2212x1659px; 45-degree field of view:
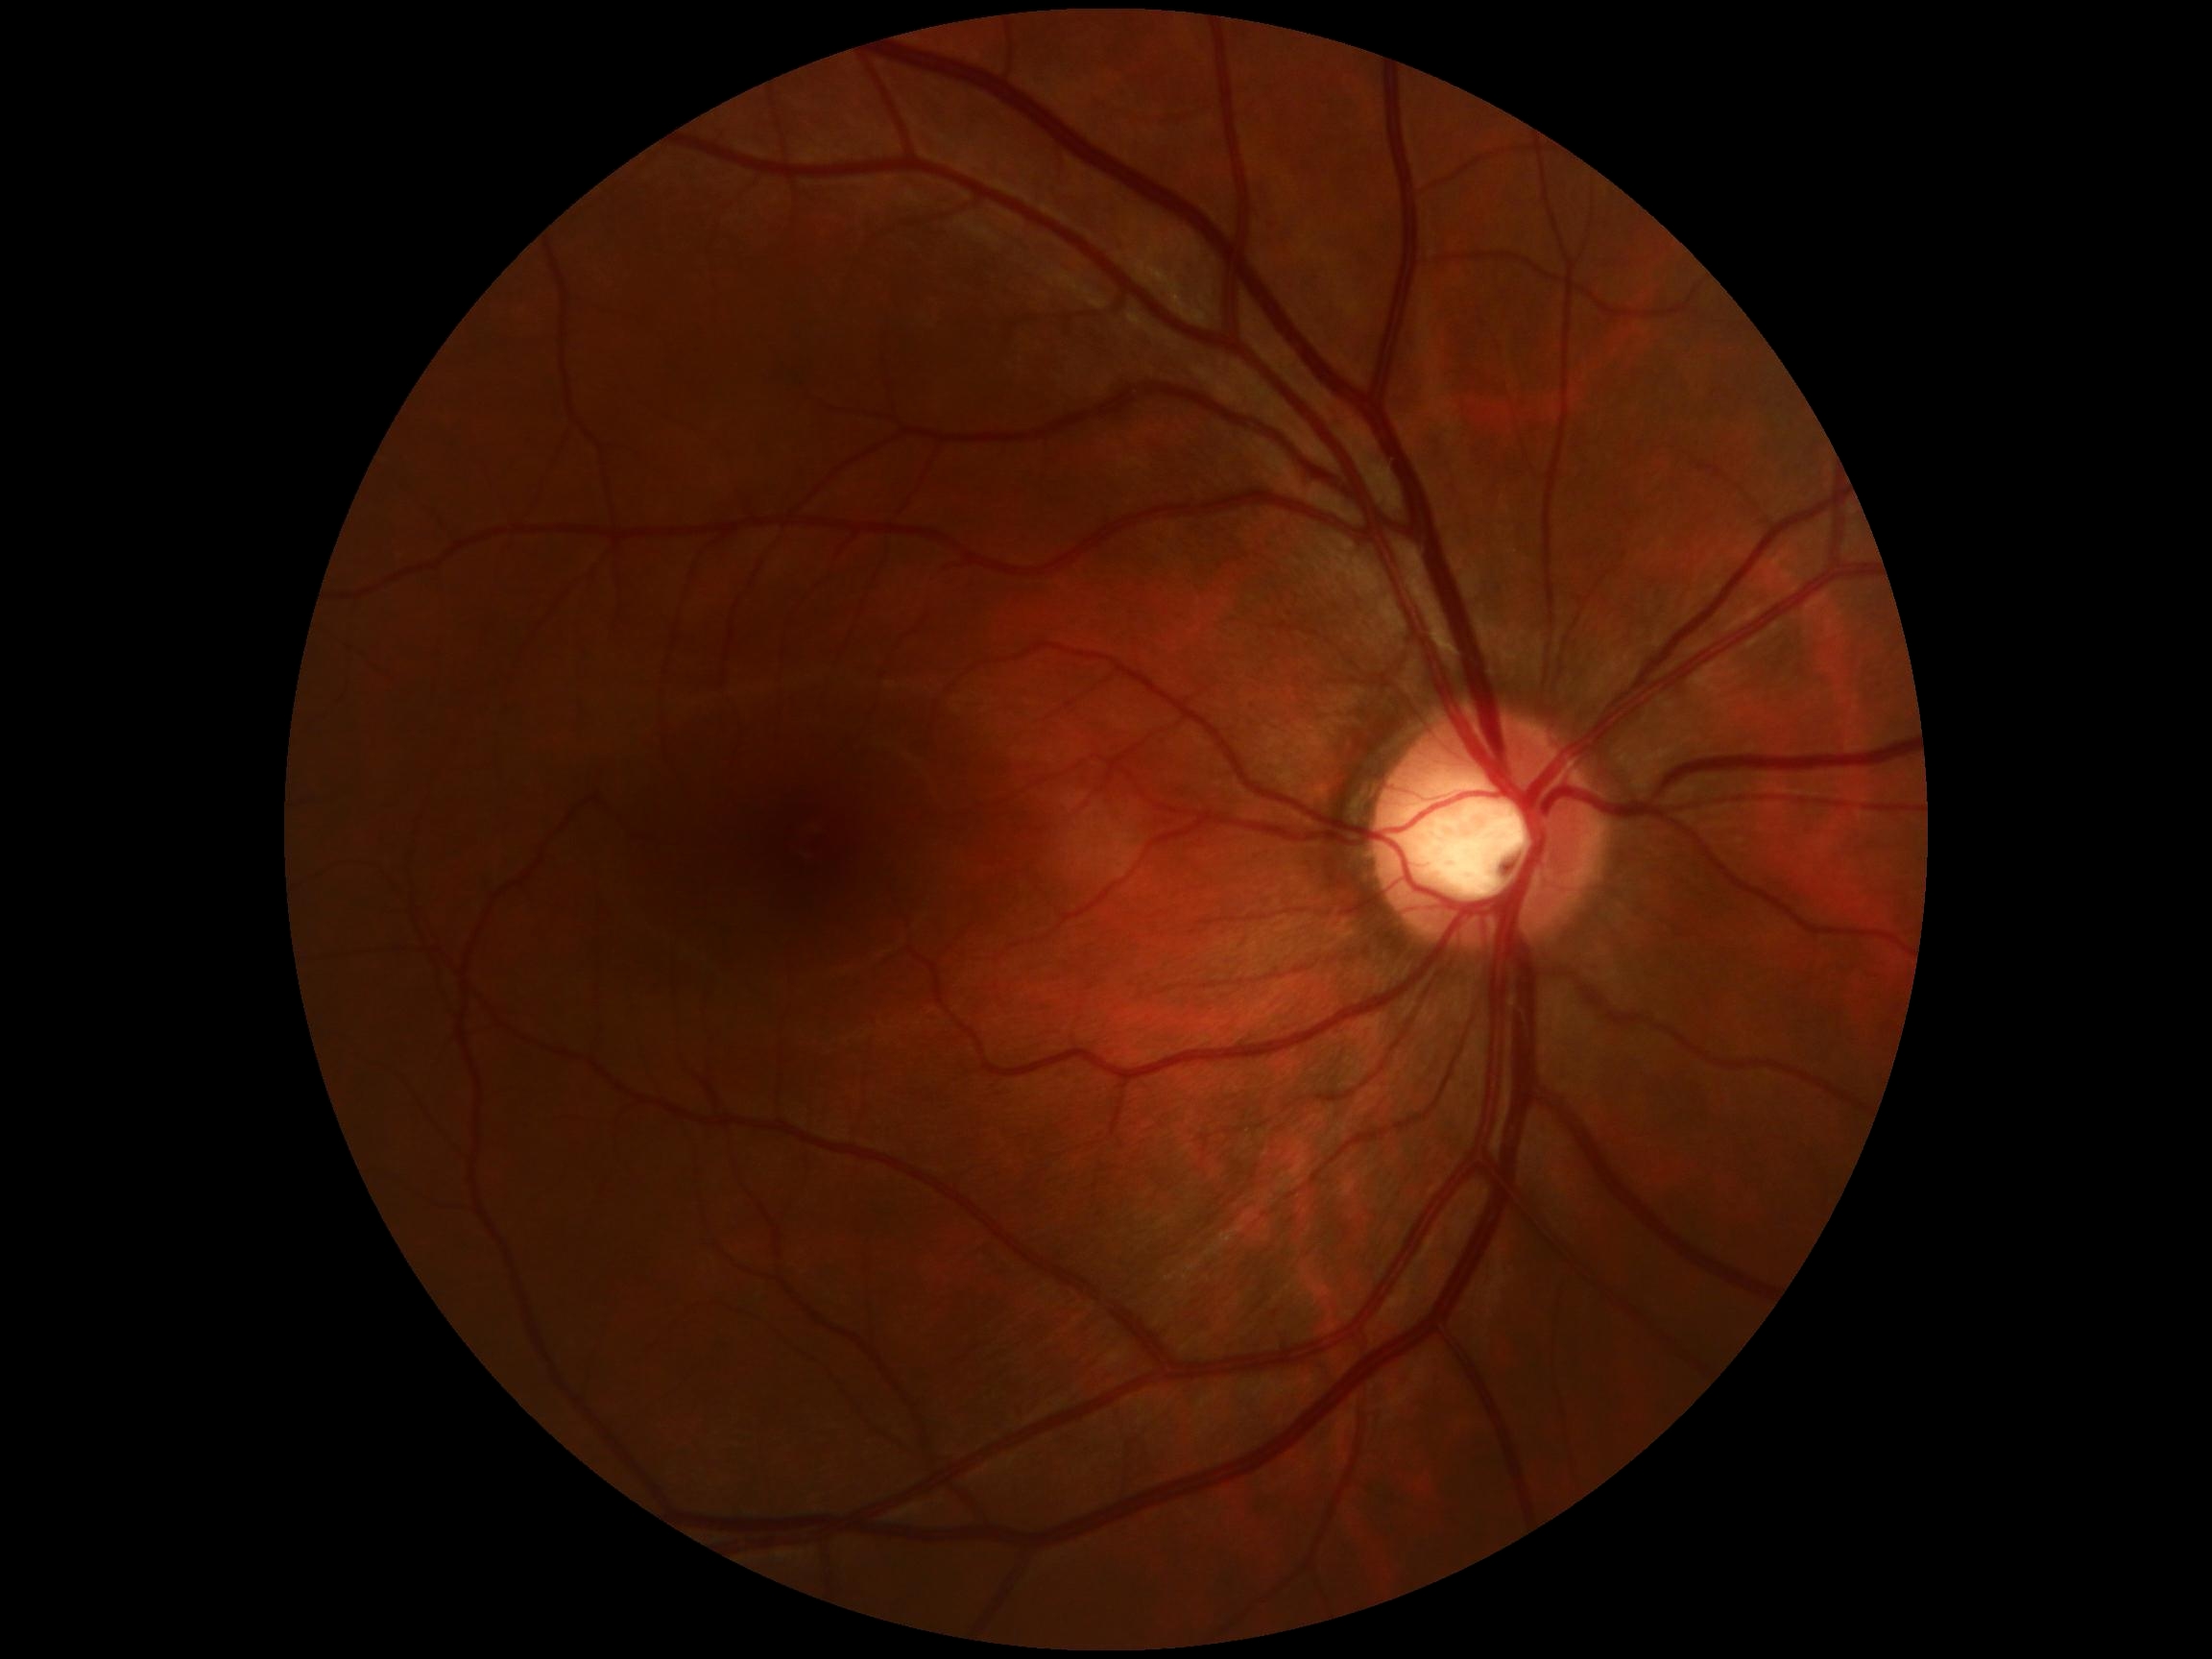

DR=0; DR impression=no DR findings.